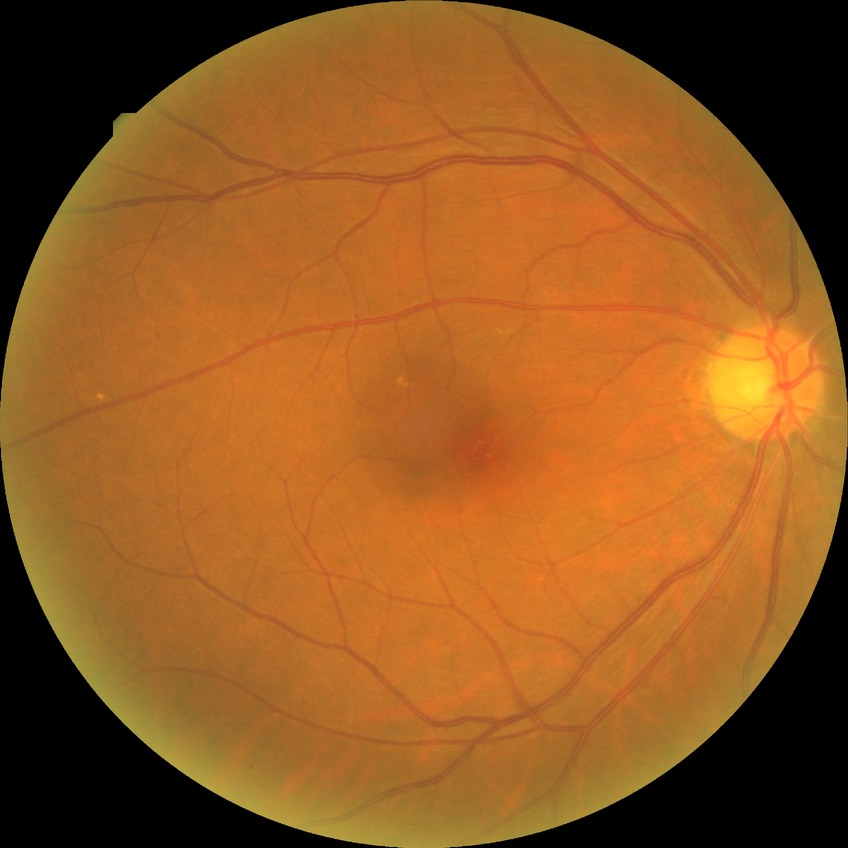

{
  "davis_grade": "no diabetic retinopathy"
}